2089 x 1764 pixels: 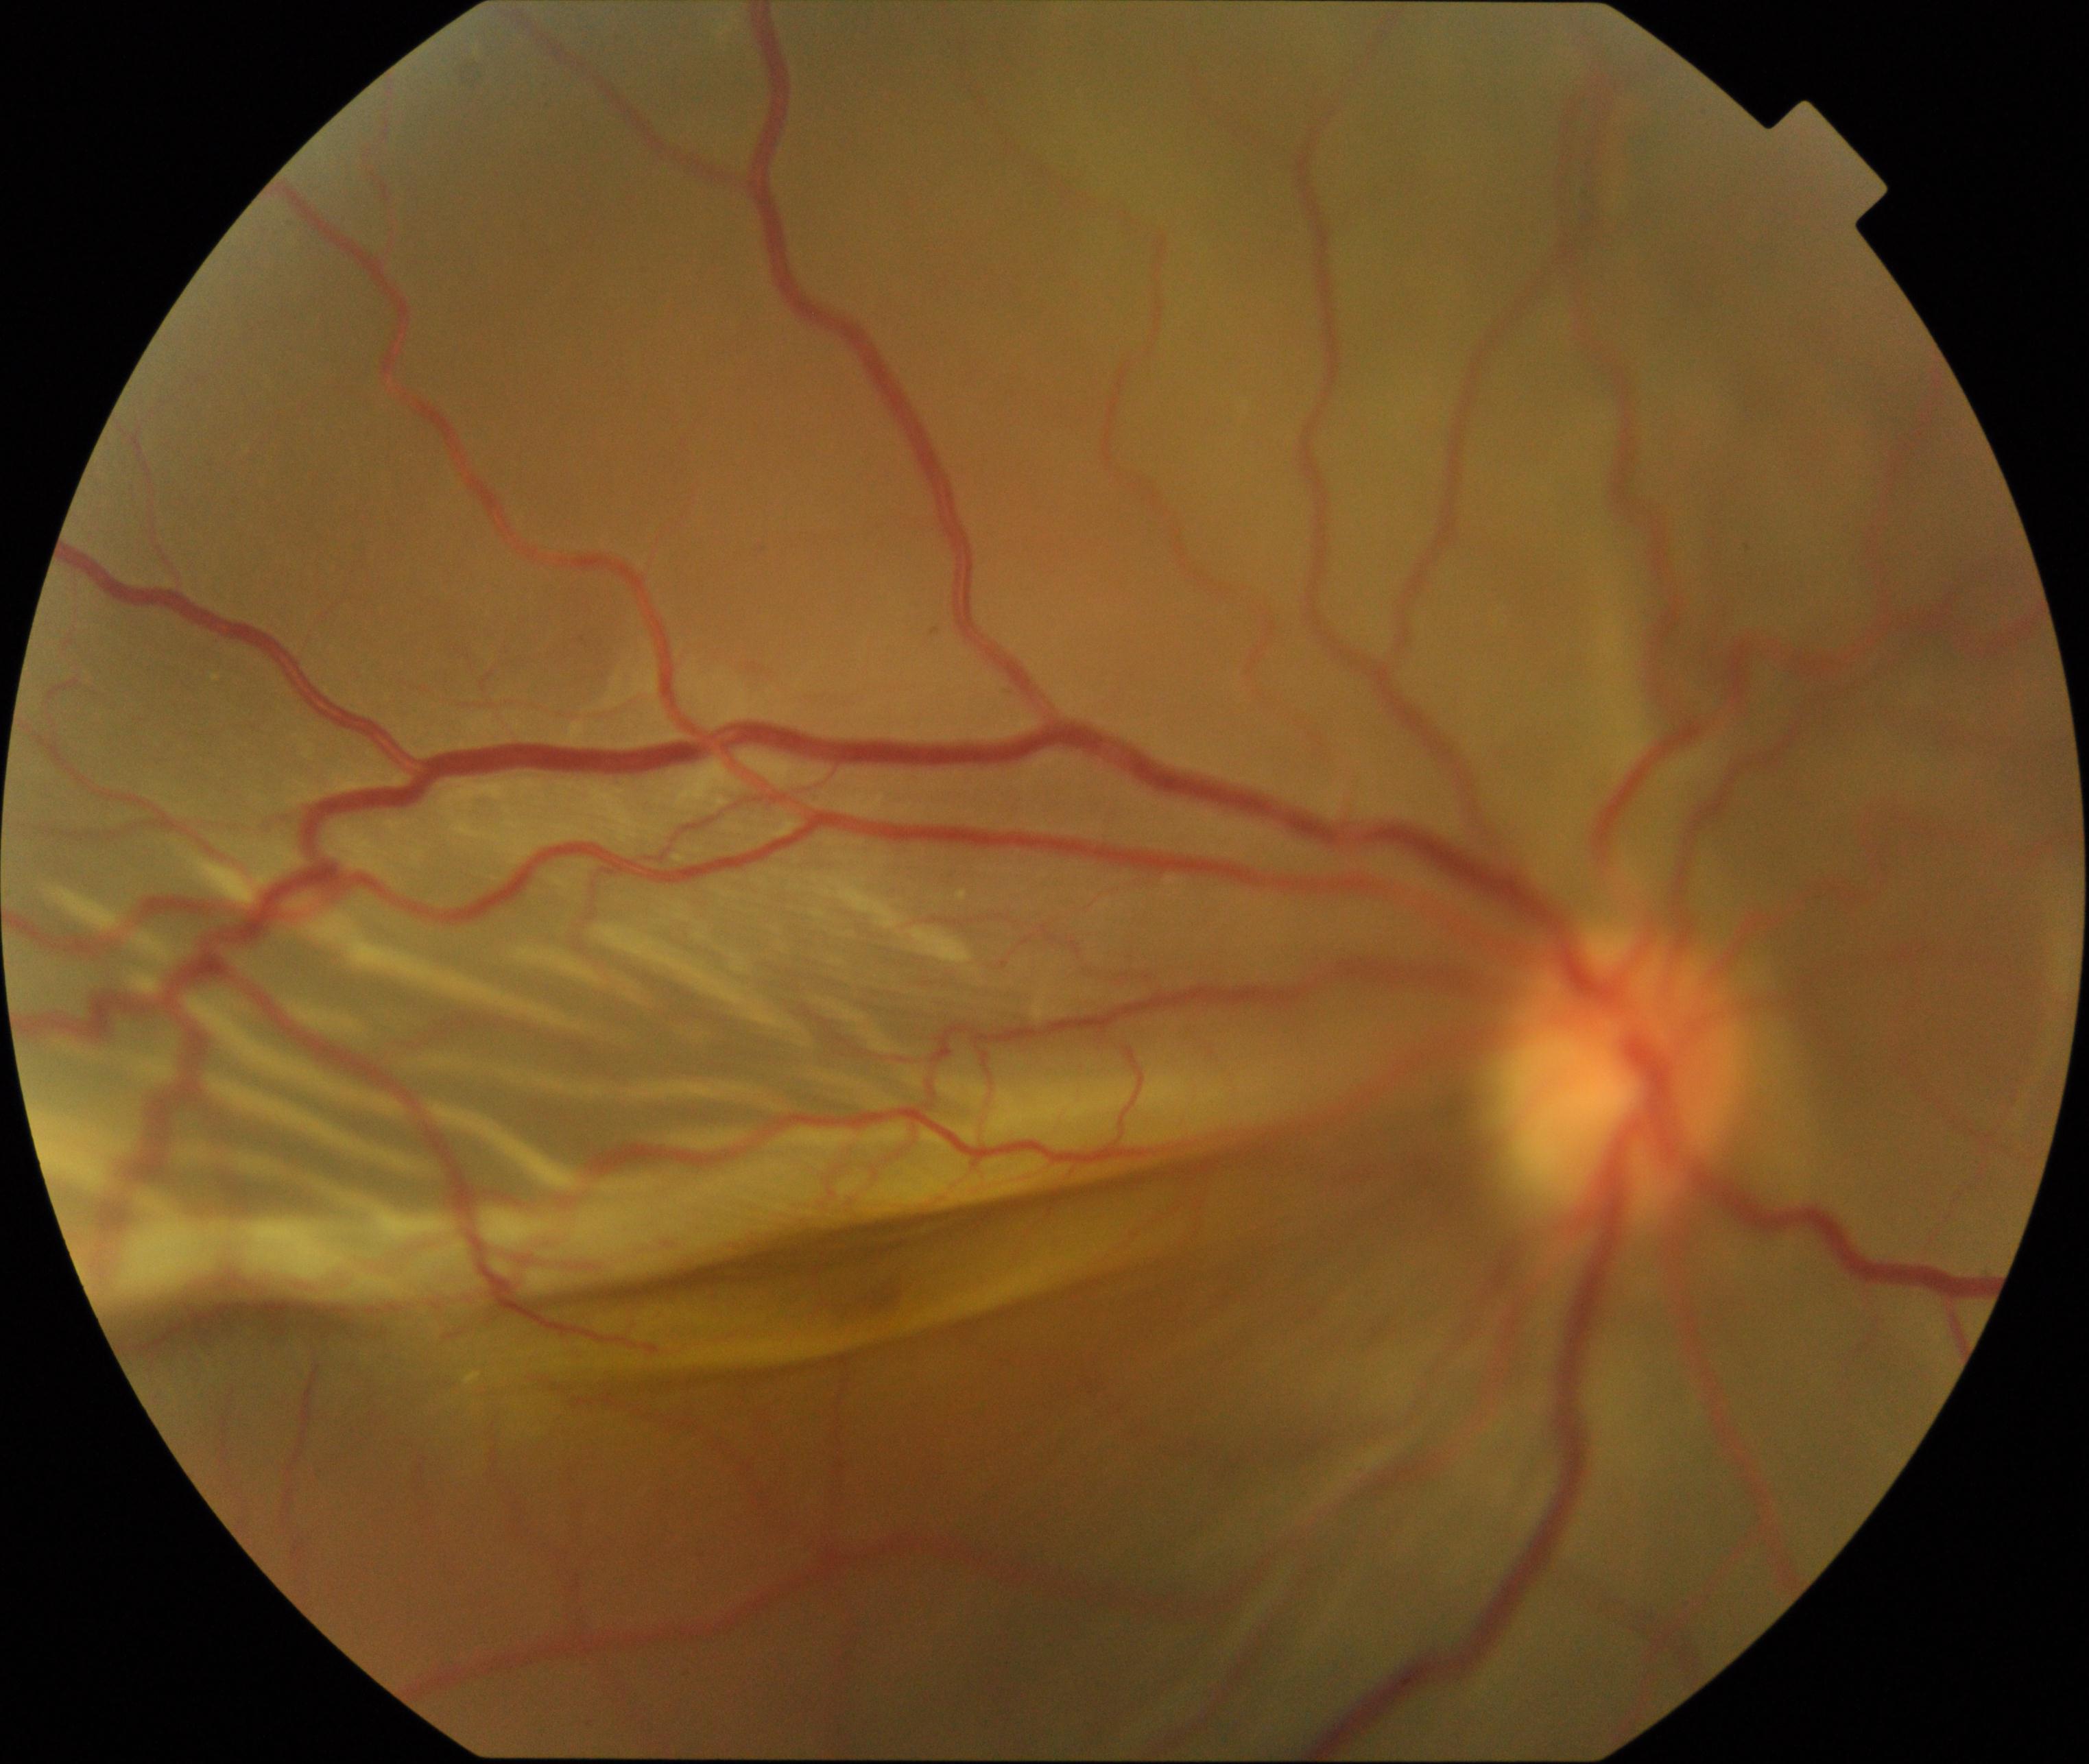 The image shows rhegmatogenous retinal detachment. Typically showing slightly opaque, convex or corrugated appearance of elevated retina, sometimes with retinal breaks in view.